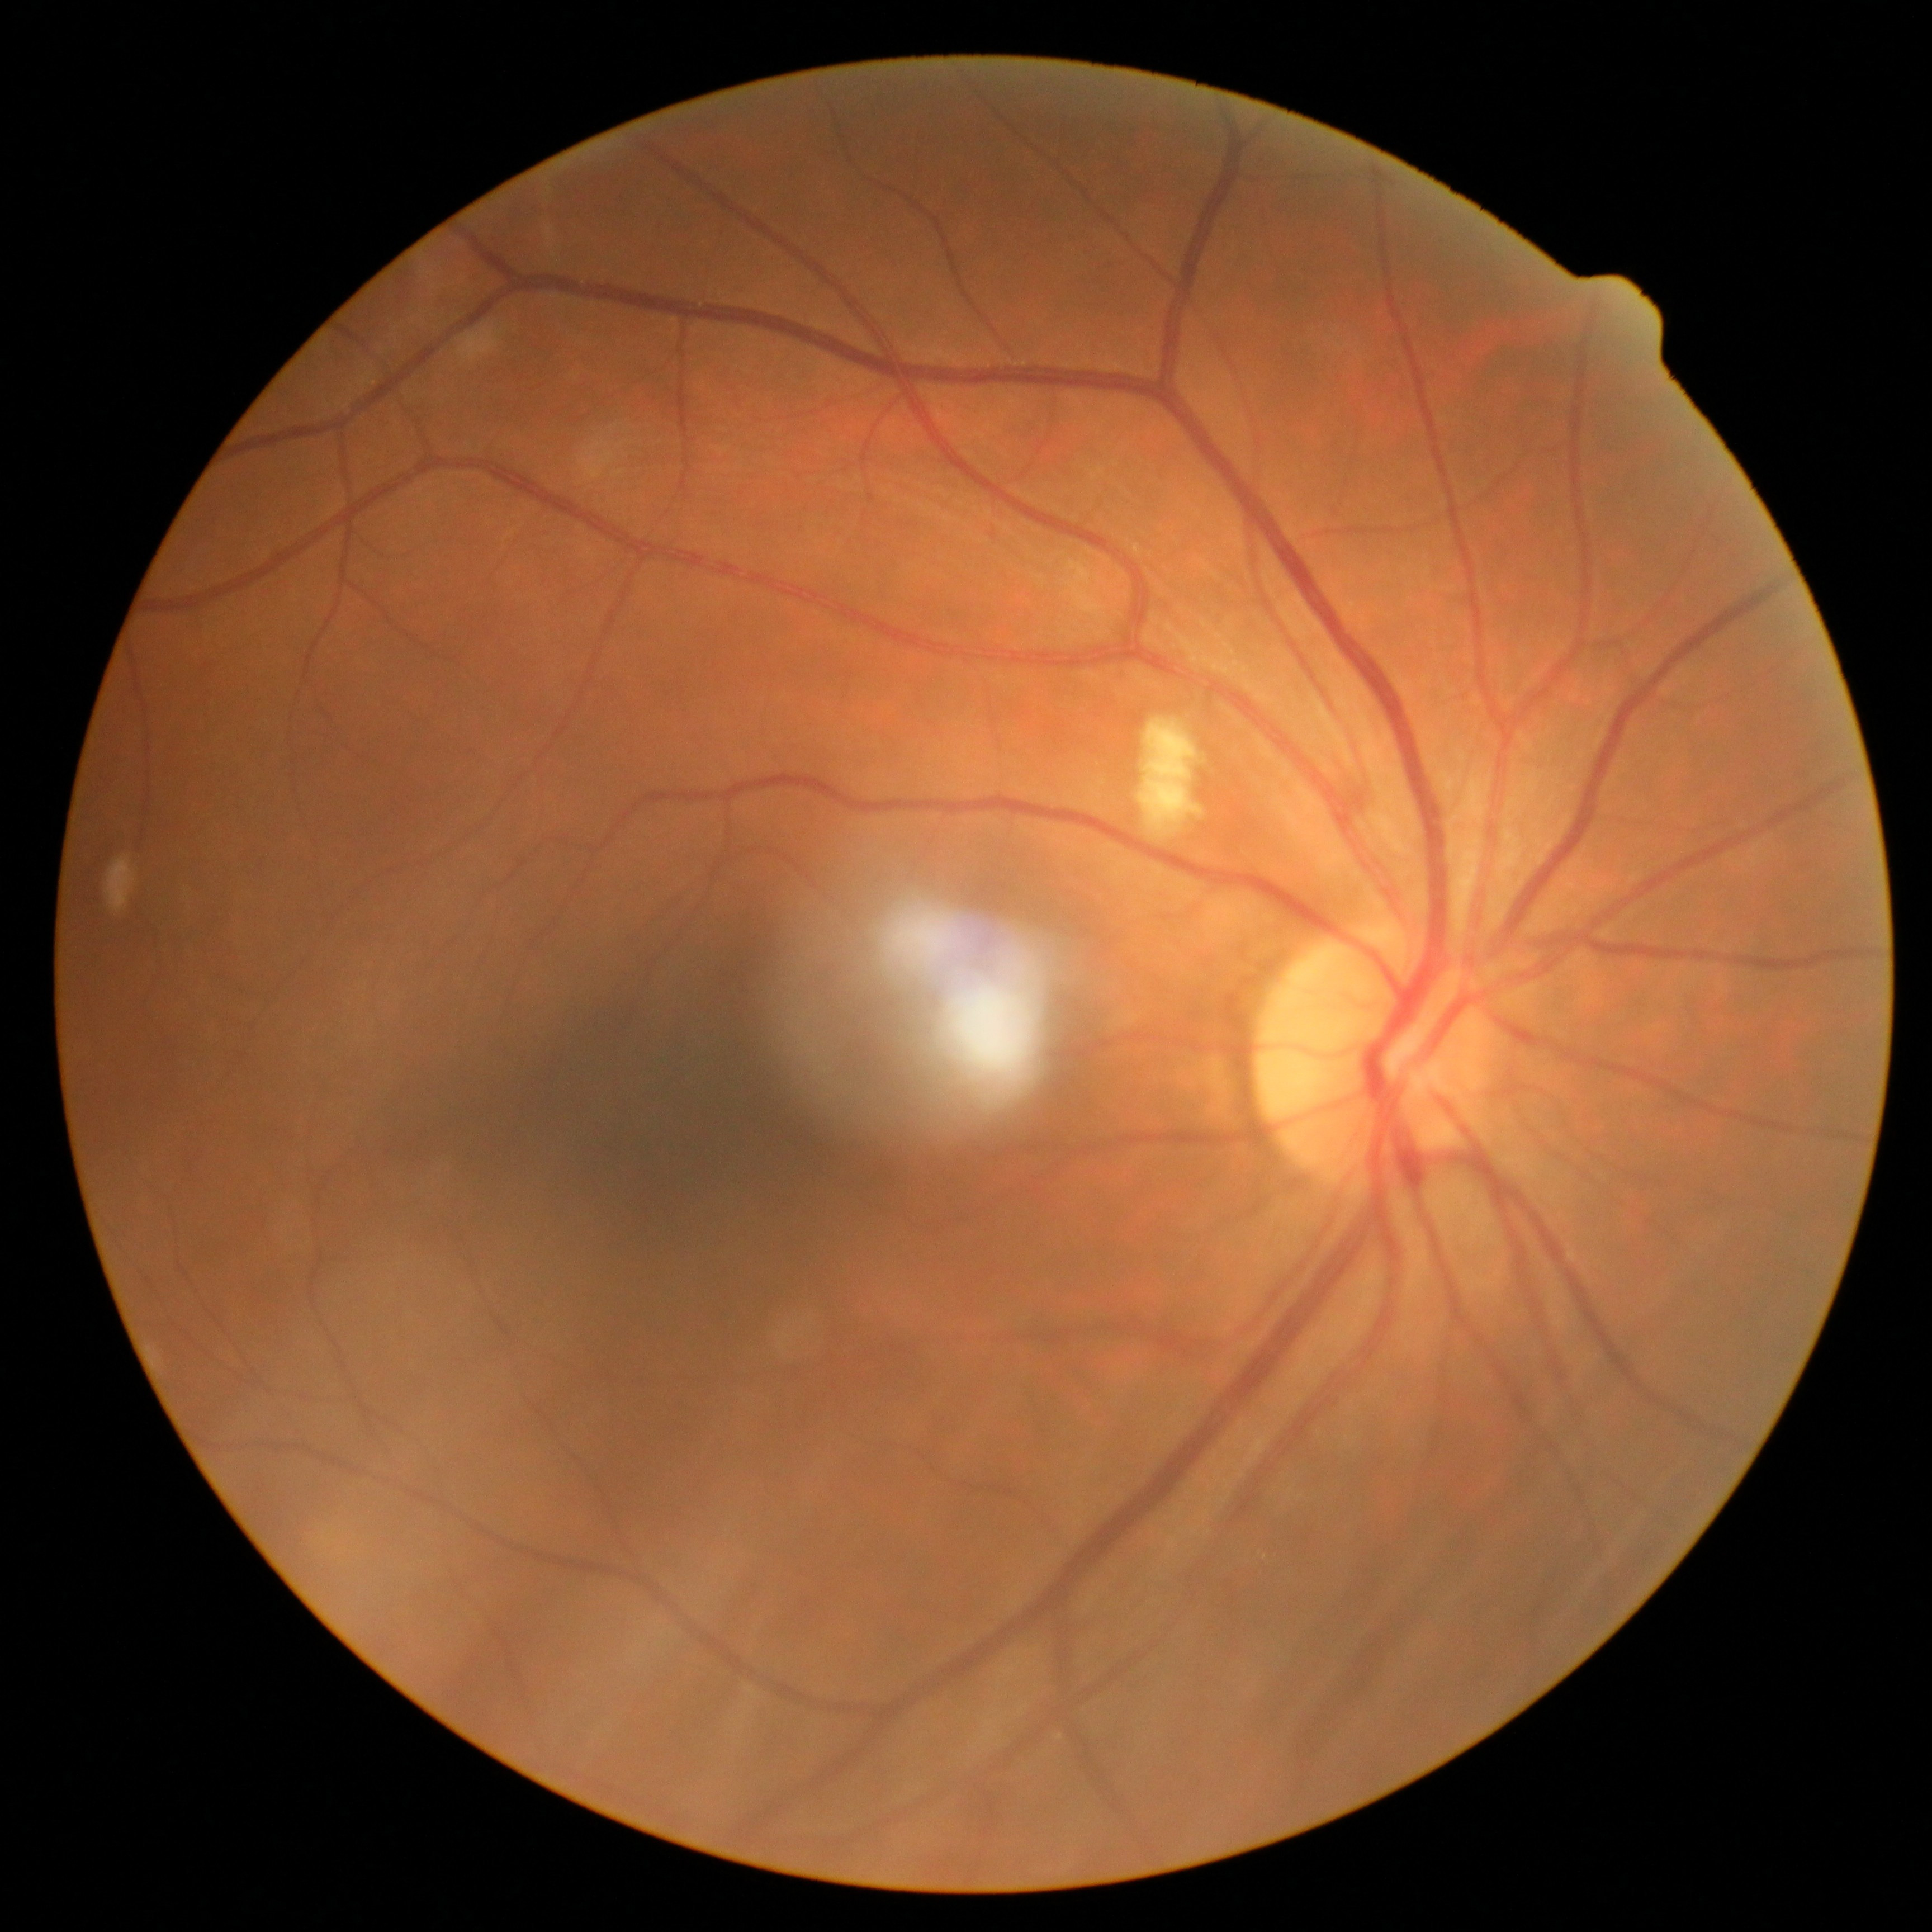 Disease class: non-proliferative diabetic retinopathy.
Diabetic retinopathy (DR) is grade 2.